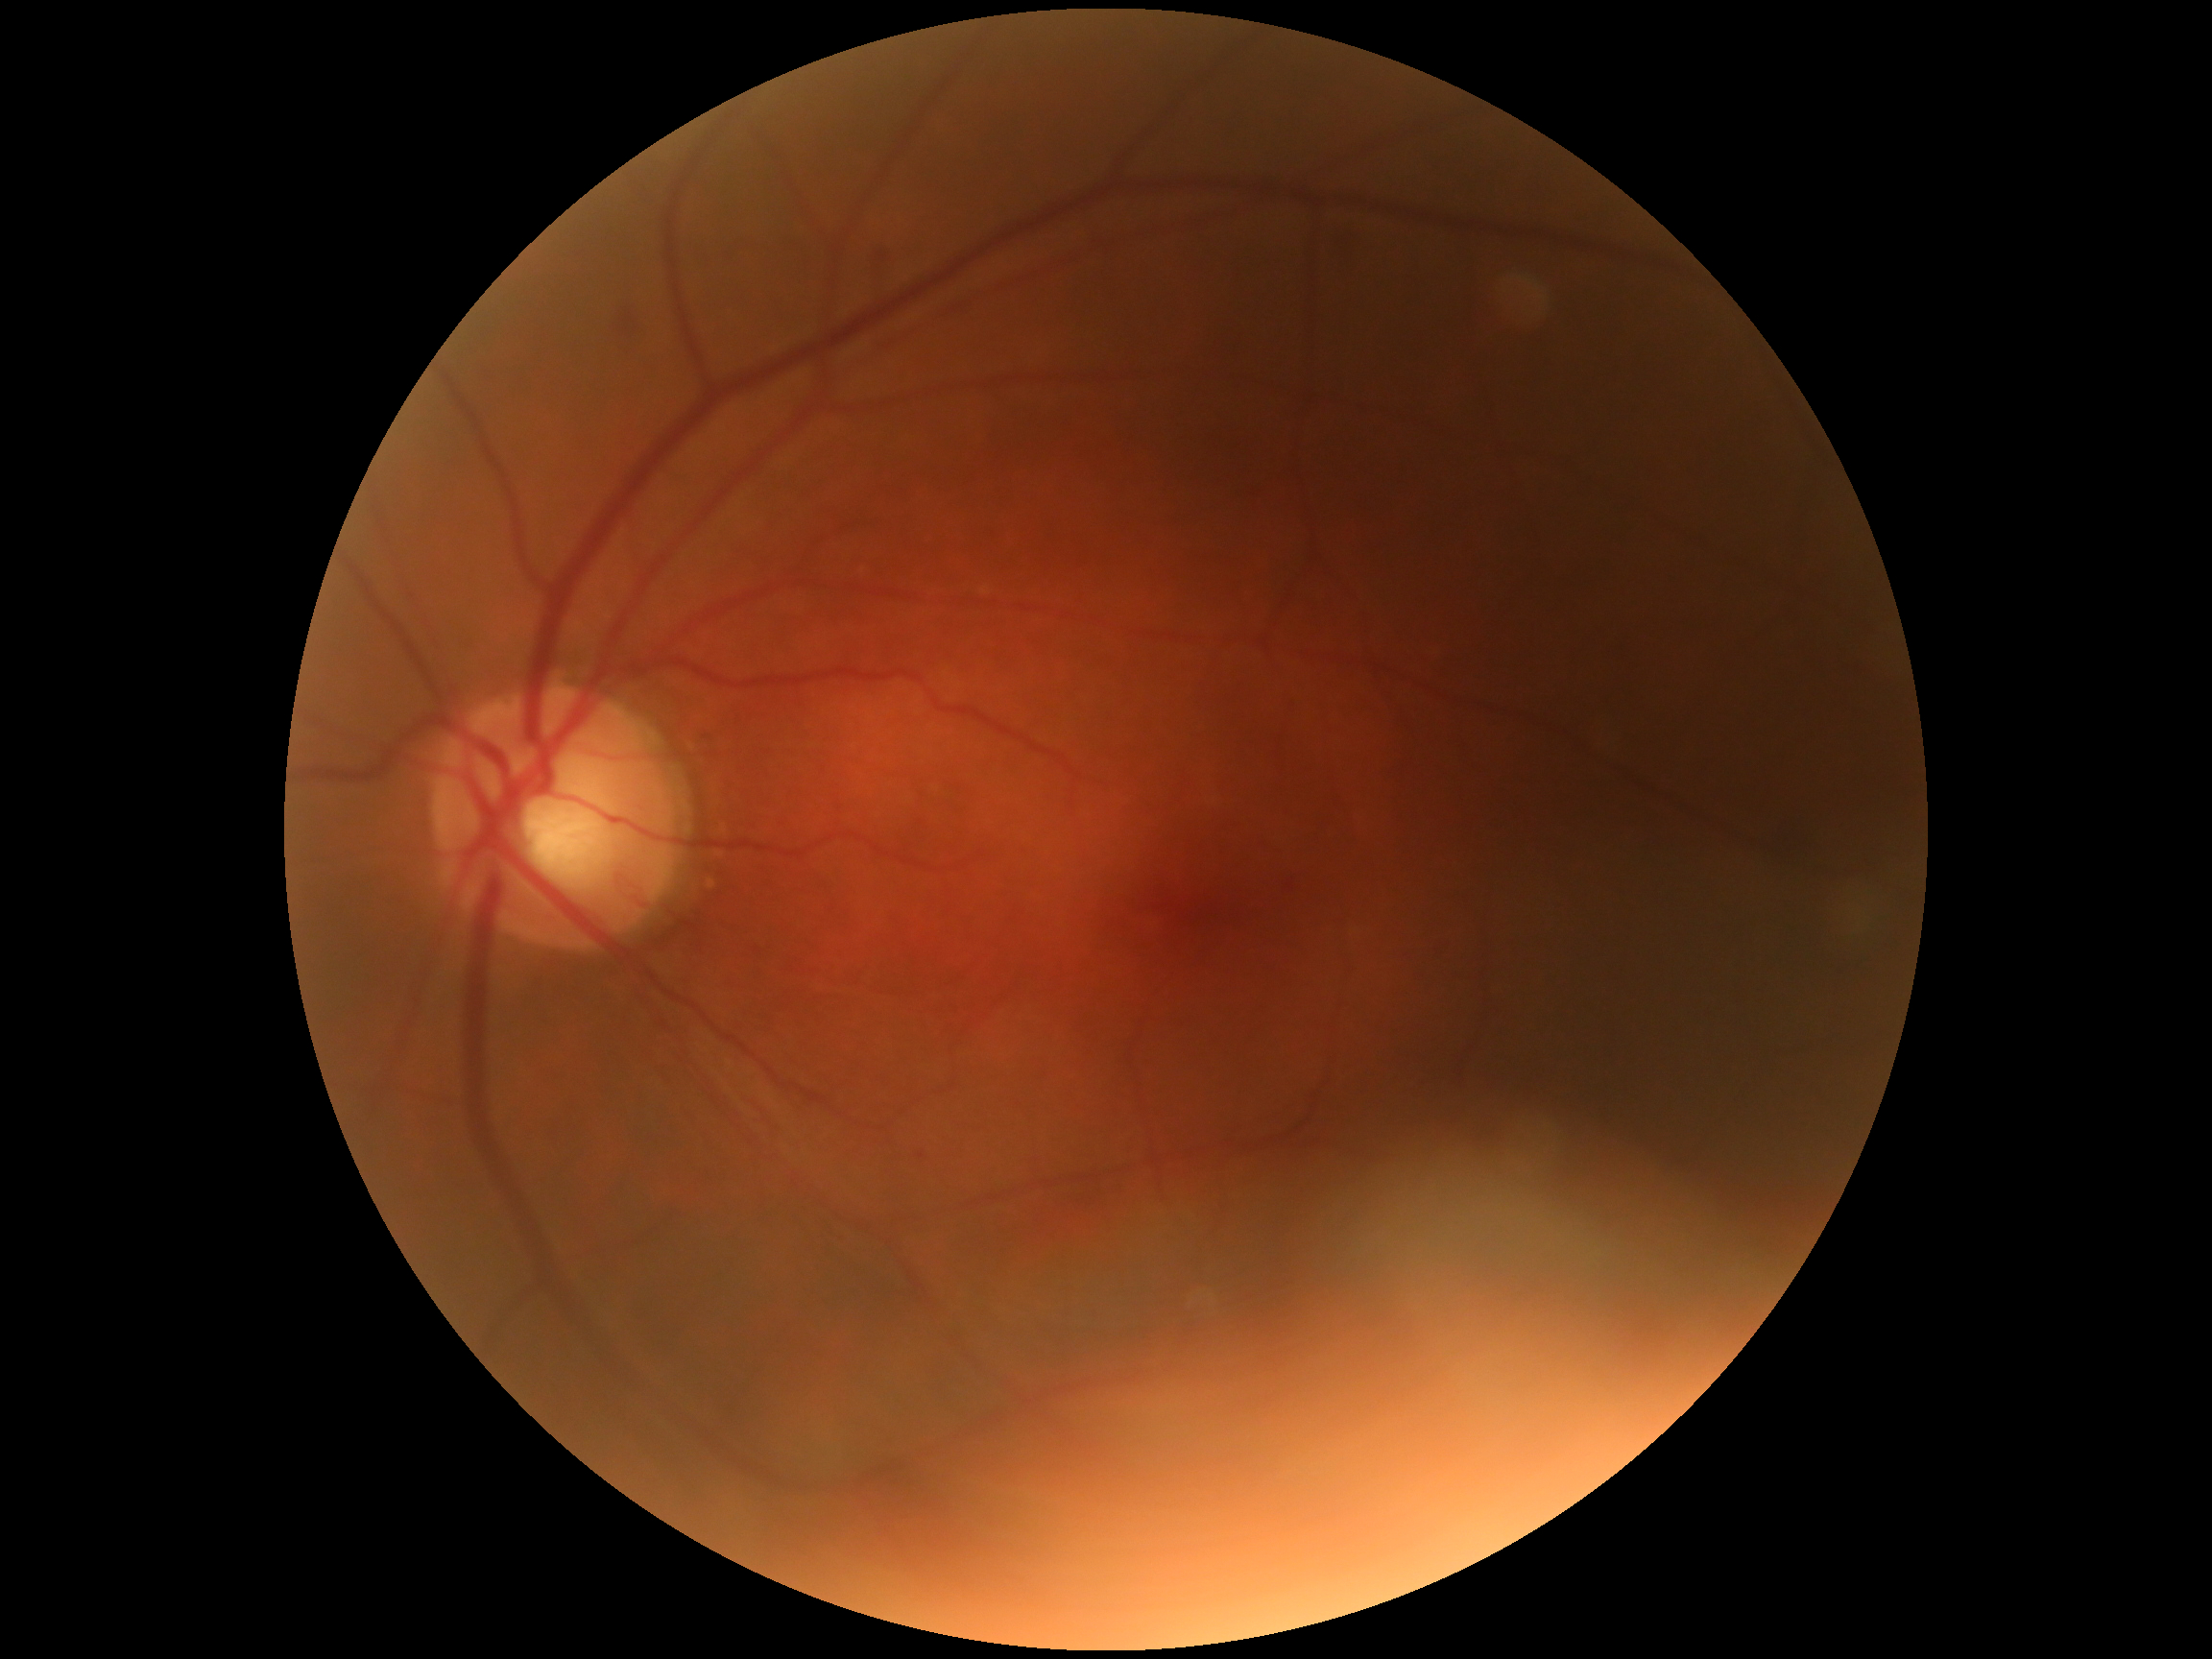
Diabetic retinopathy (DR): grade 2 (moderate NPDR).